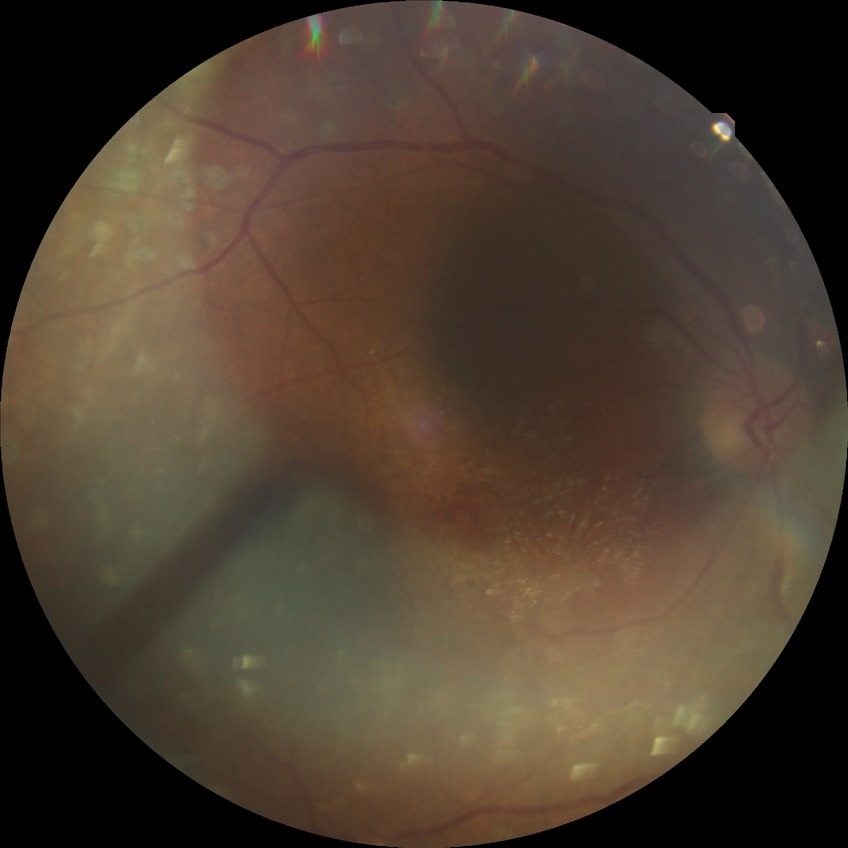

diabetic retinopathy stage = proliferative diabetic retinopathy